848 by 848 pixels: 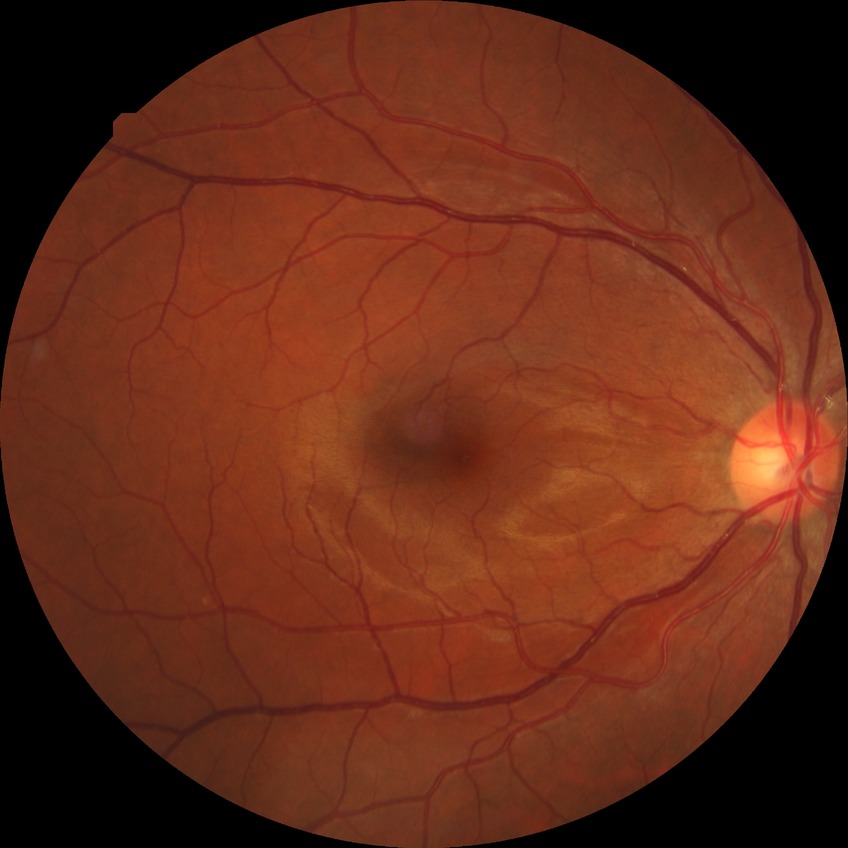 Findings:
- diabetic retinopathy (DR) — no diabetic retinopathy (NDR)